Davis DR grading.
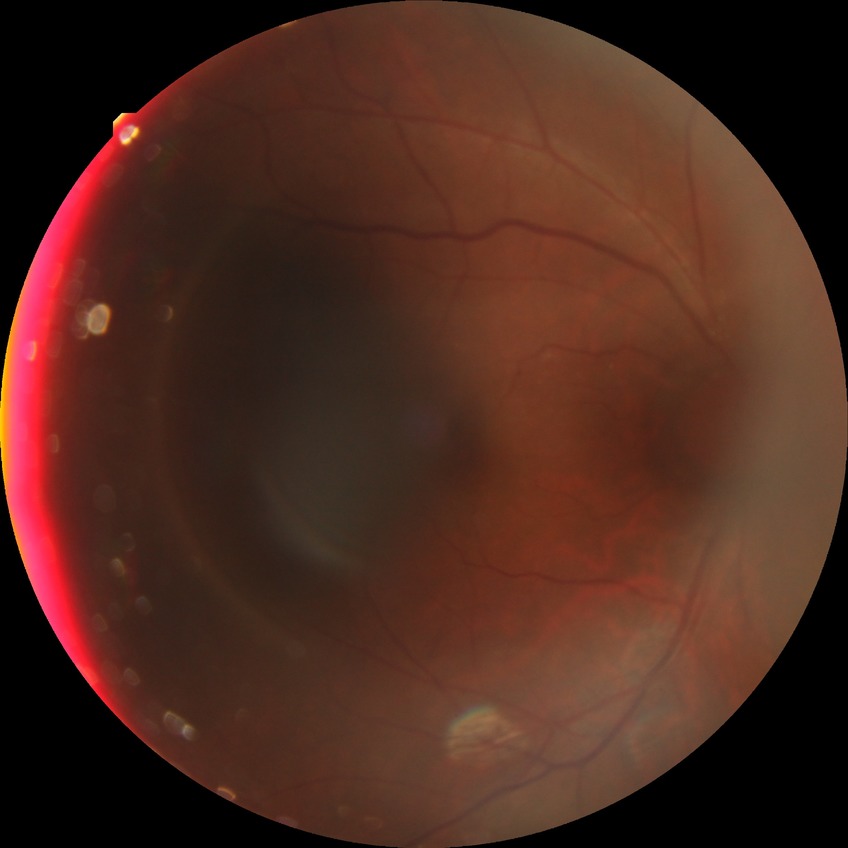
Annotations:
• DR stage: NDR